Pediatric retinal photograph (wide-field); Phoenix ICON, 100° FOV:
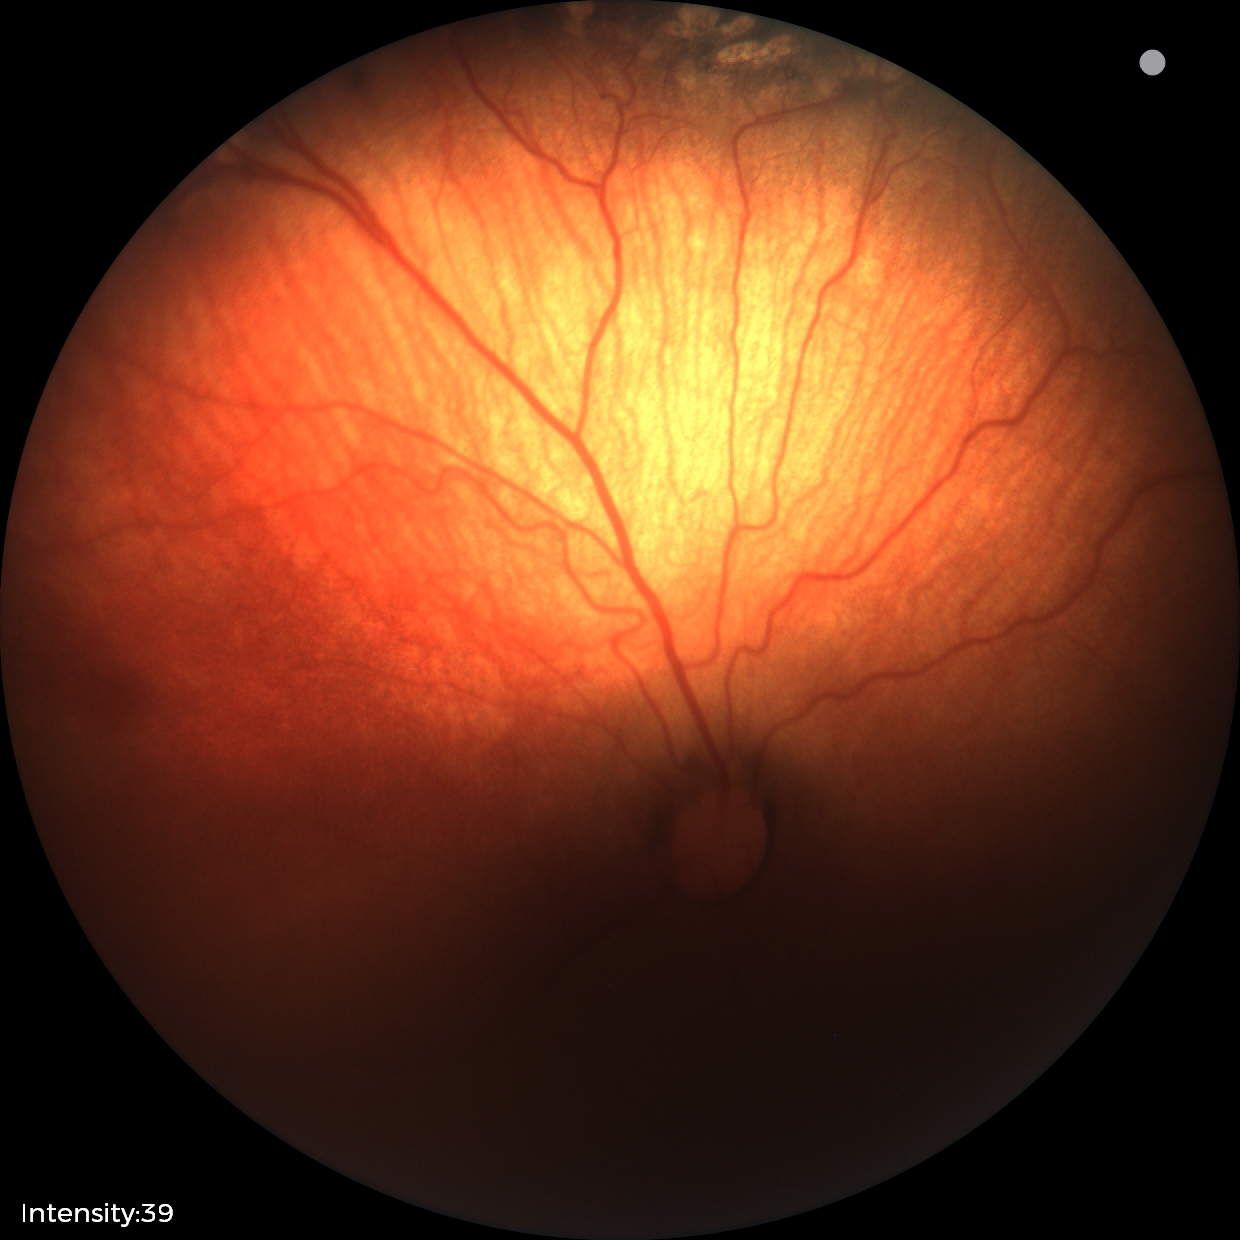
Screening series with status post retinopathy of prematurity (ROP).